45 degree fundus photograph; 848x848px; CFP:
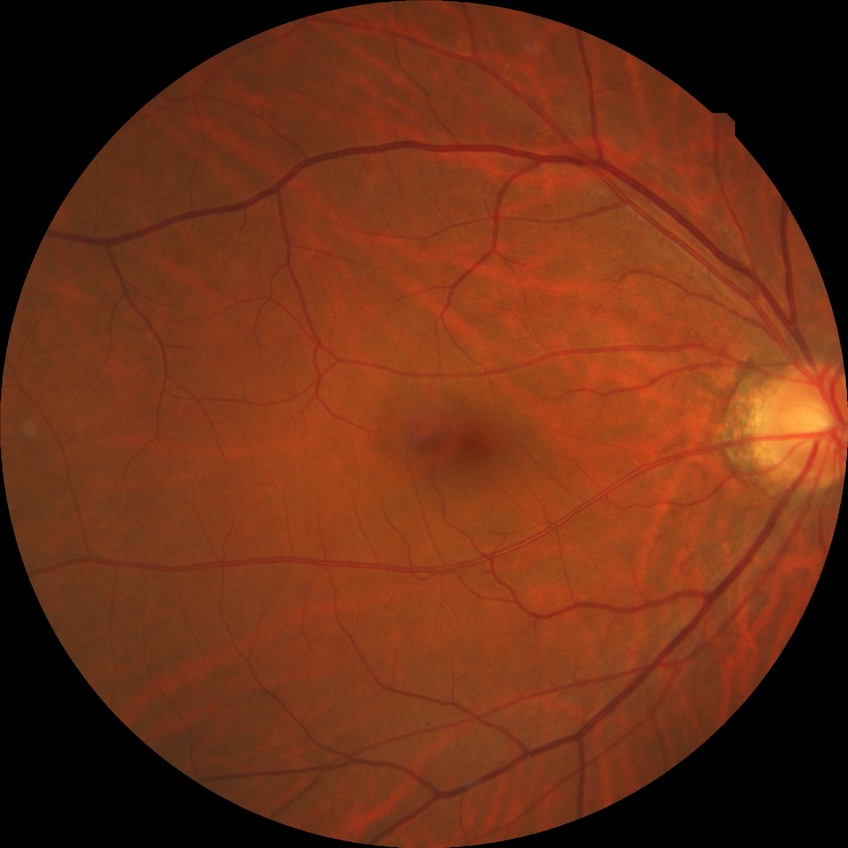 davis_grade: no diabetic retinopathy (NDR)